Image size 1536x1152:
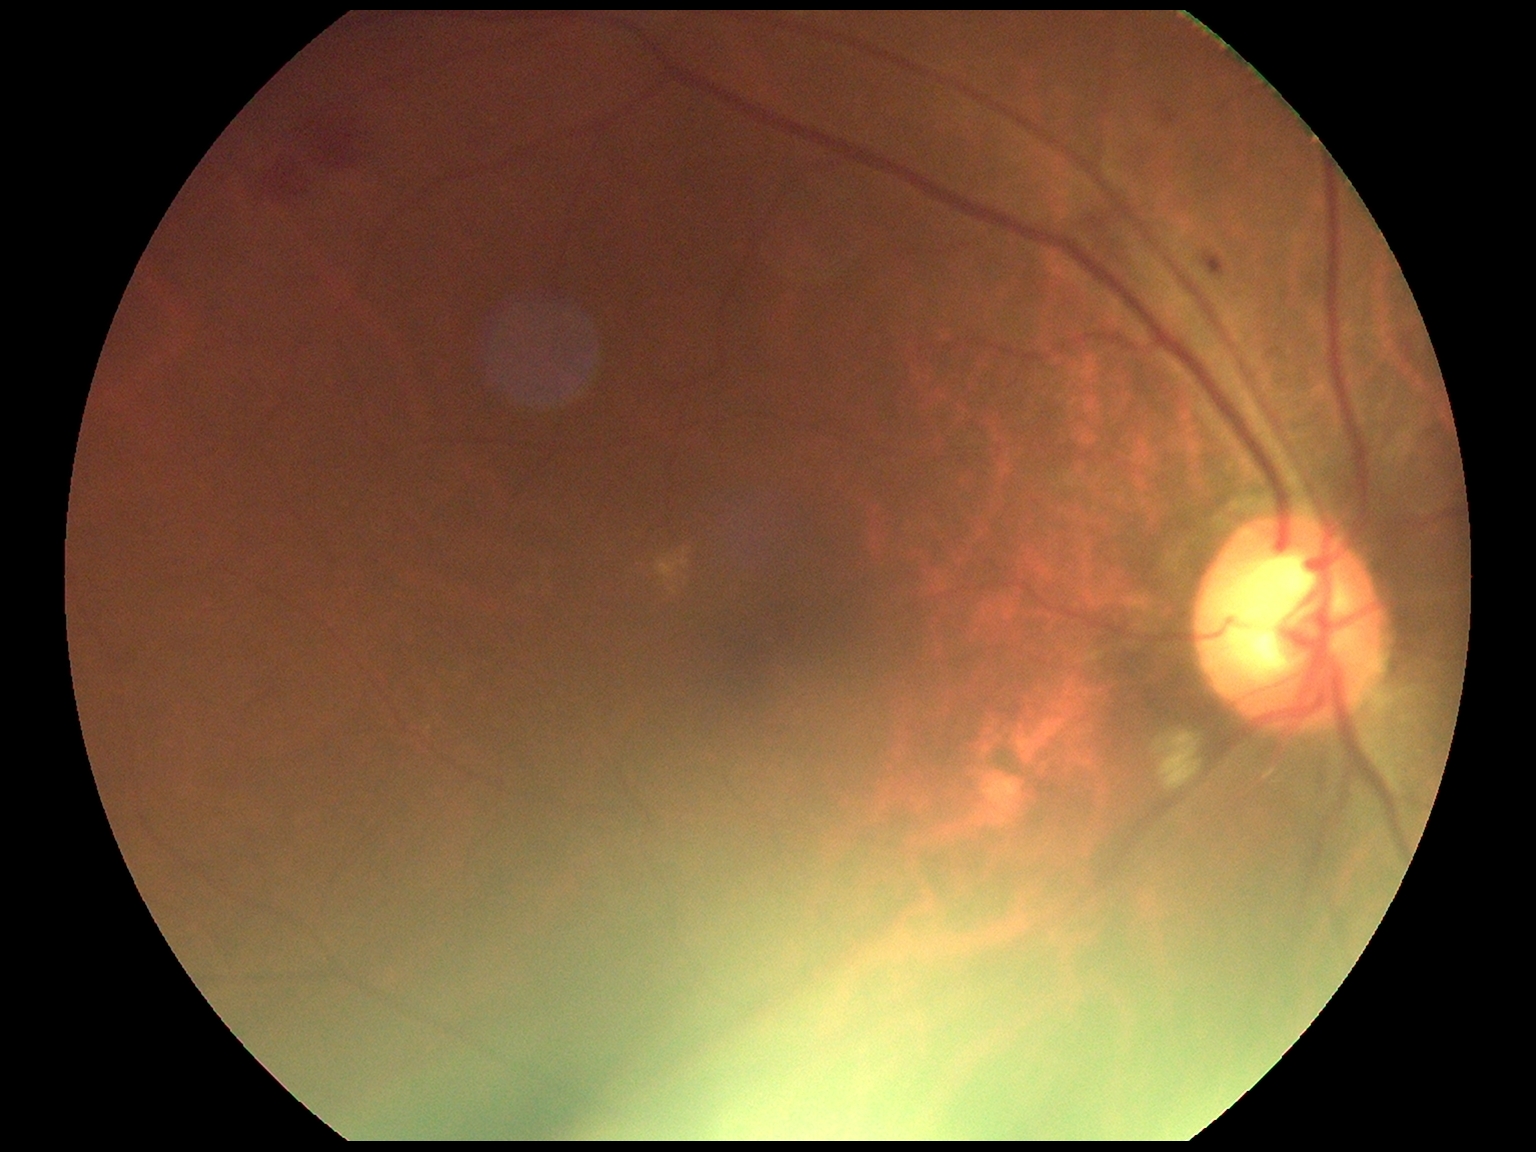 {"dr_grade": "grade 2 (moderate NPDR)"}